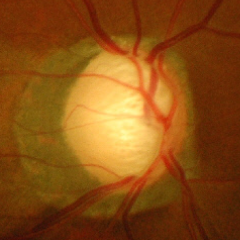 This fundus photograph shows advanced-stage glaucoma.